30-degree field of view. Non-mydriatic. Retinal fundus photograph. Acquired with a Topcon TRC-NW400. Disc-centered field — 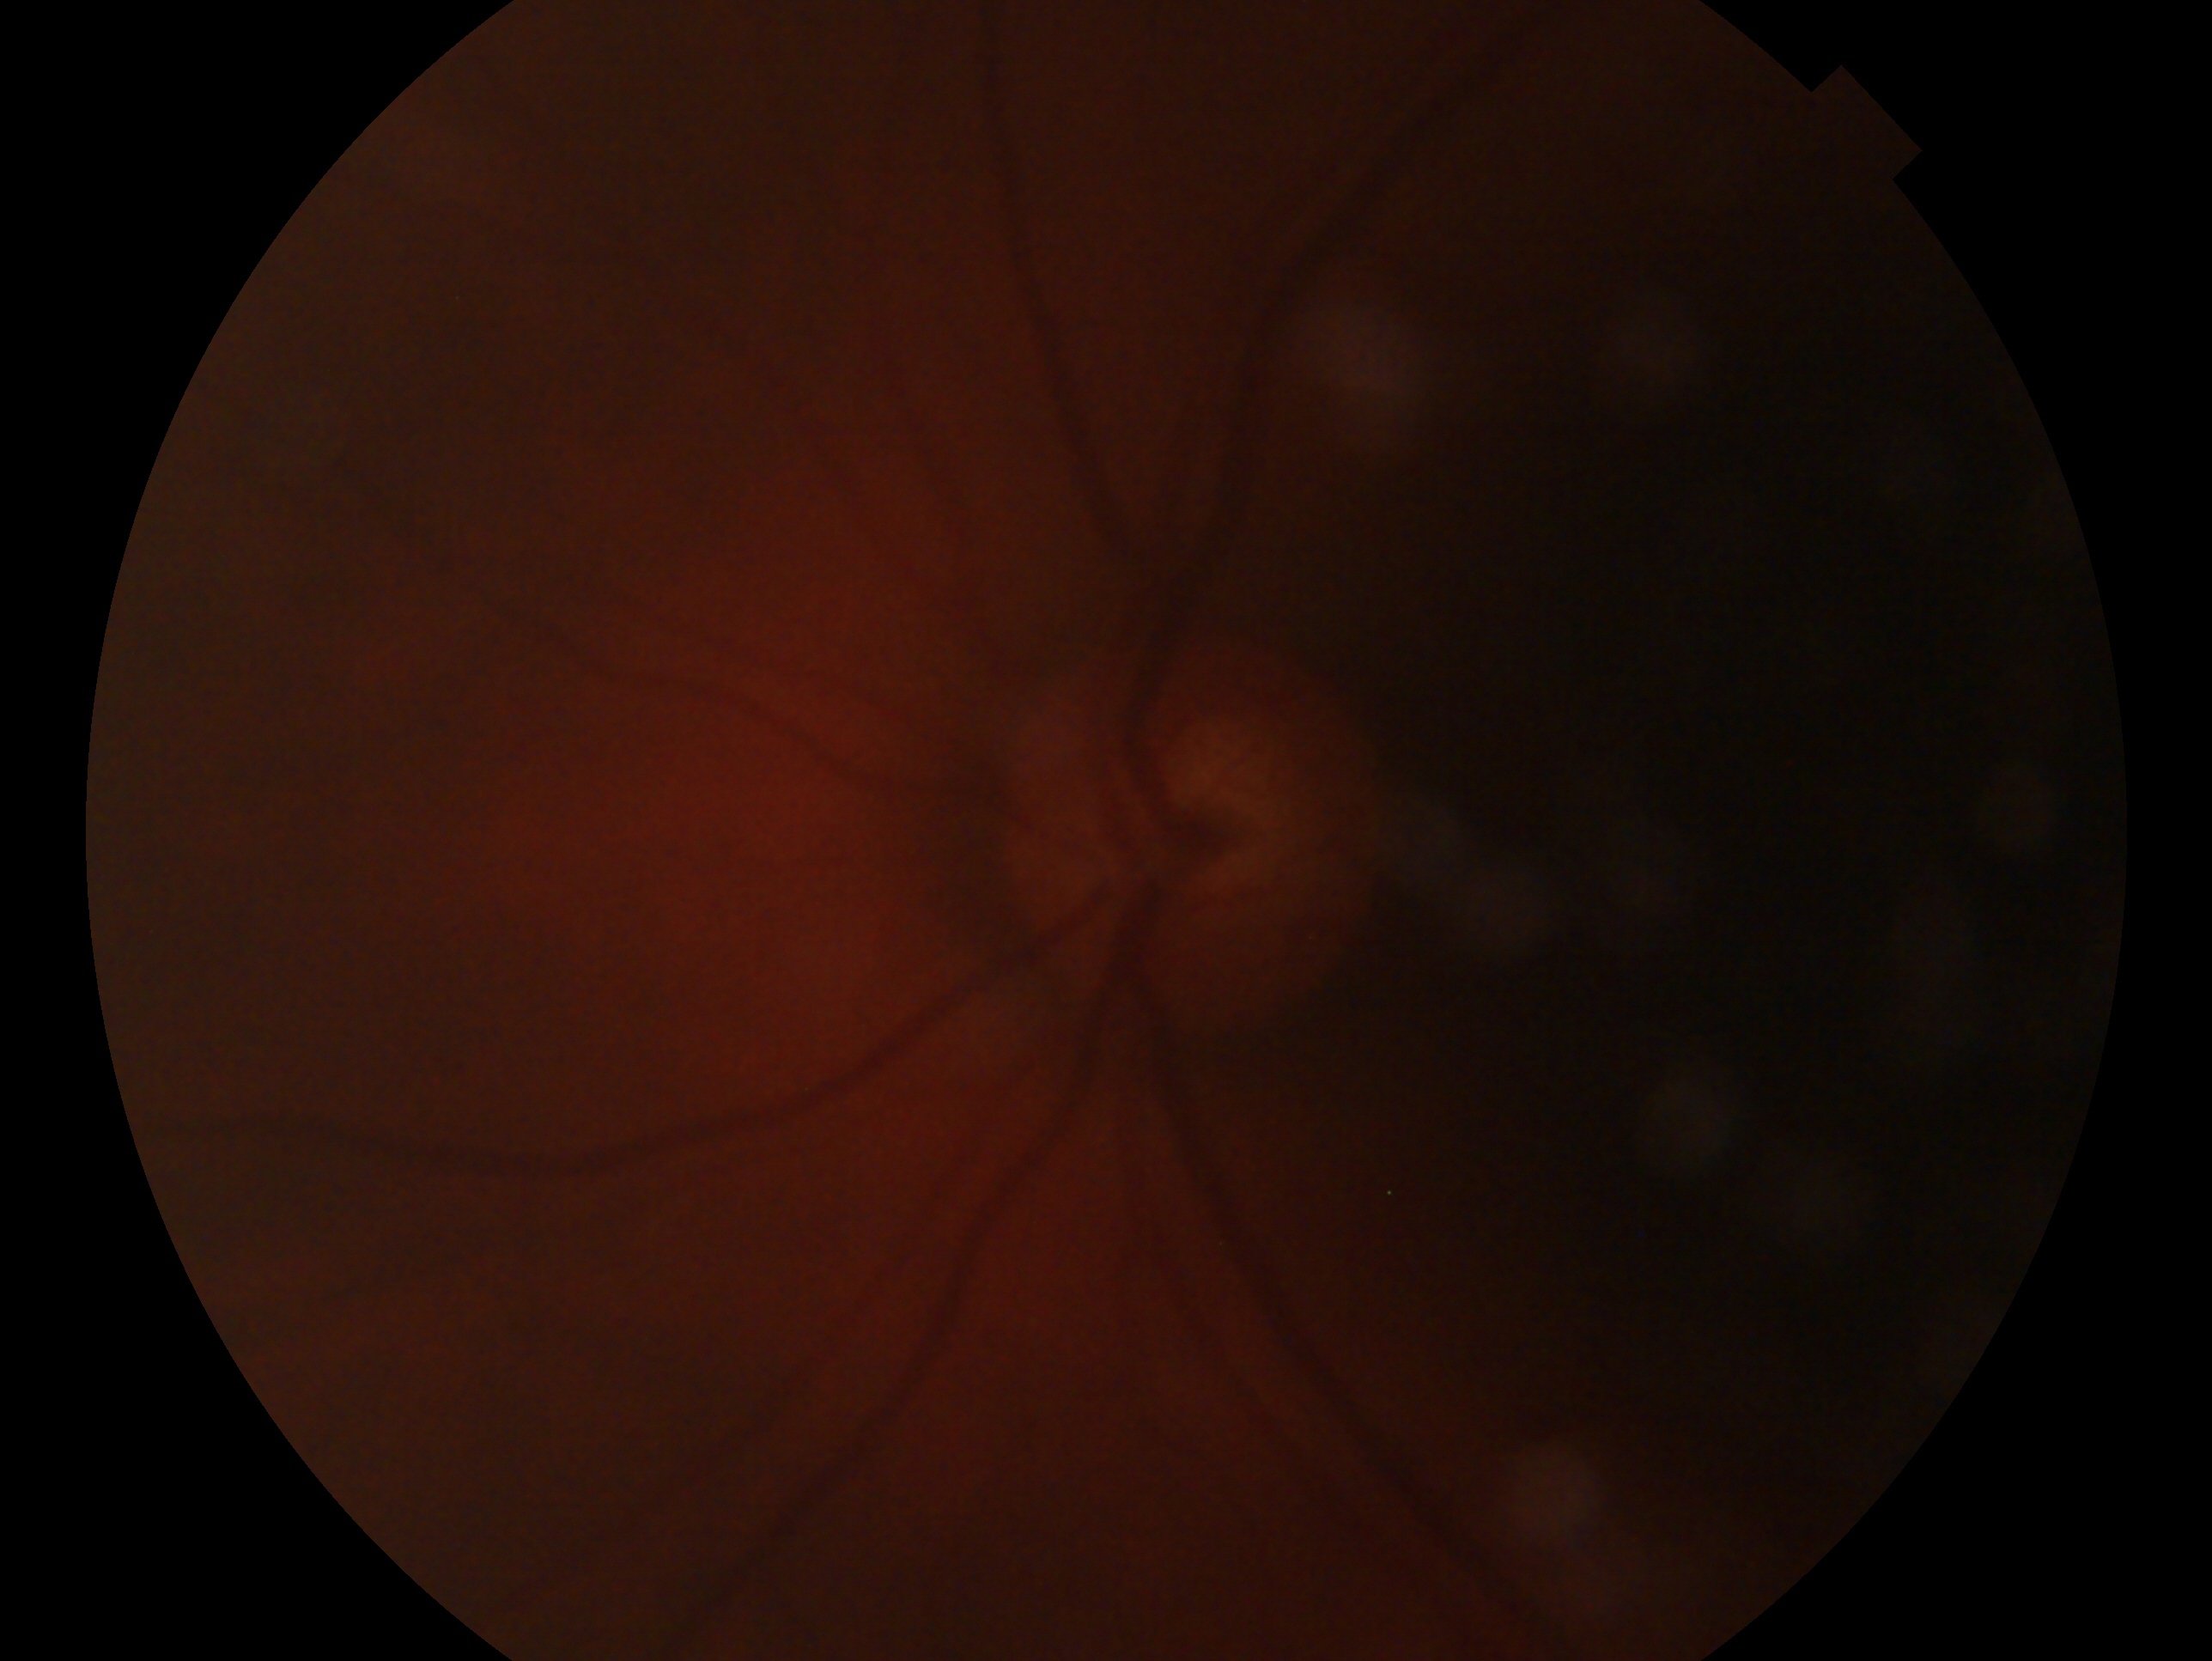 Glaucoma status: no glaucomatous findings. Imaged eye: oculus sinister.